45° FOV. Modified Davis classification.
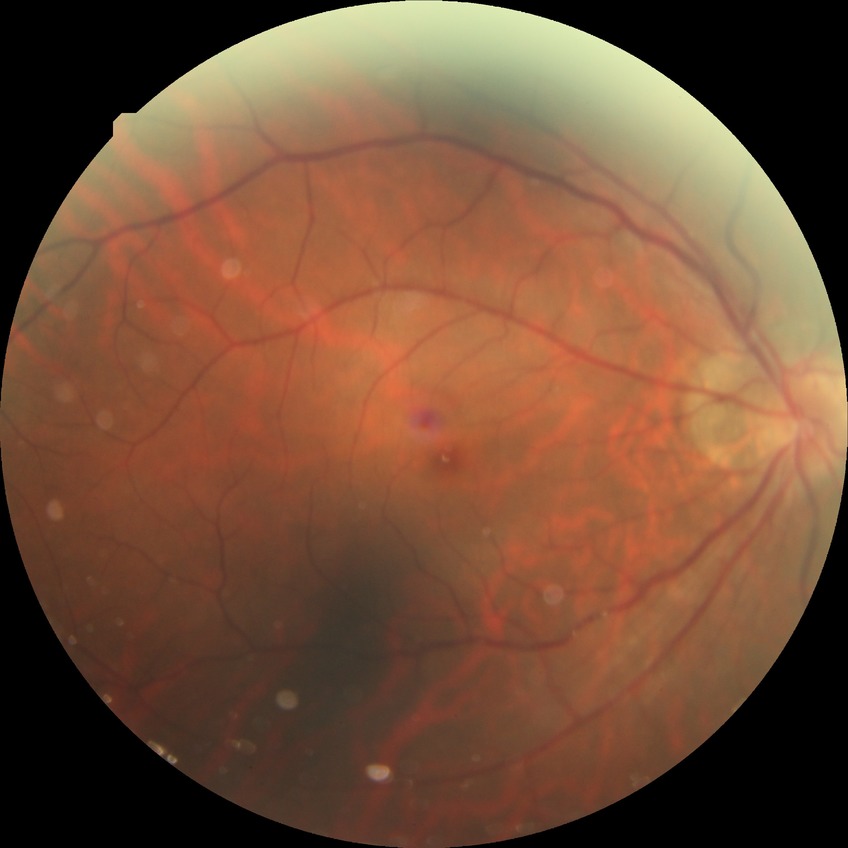
Diabetic retinopathy (DR) is NDR (no diabetic retinopathy).